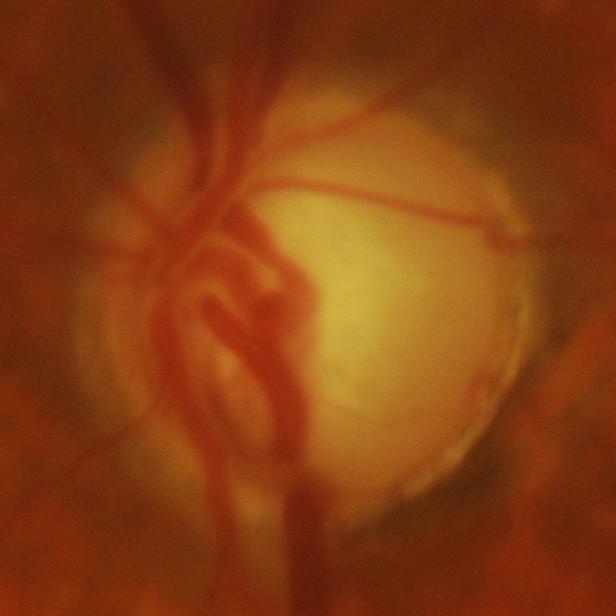

Glaucomatous optic neuropathy is present. Optic disc photograph showing glaucomatous damage to the optic nerve.